Modified Davis classification, without pupil dilation, acquired with a NIDEK AFC-230
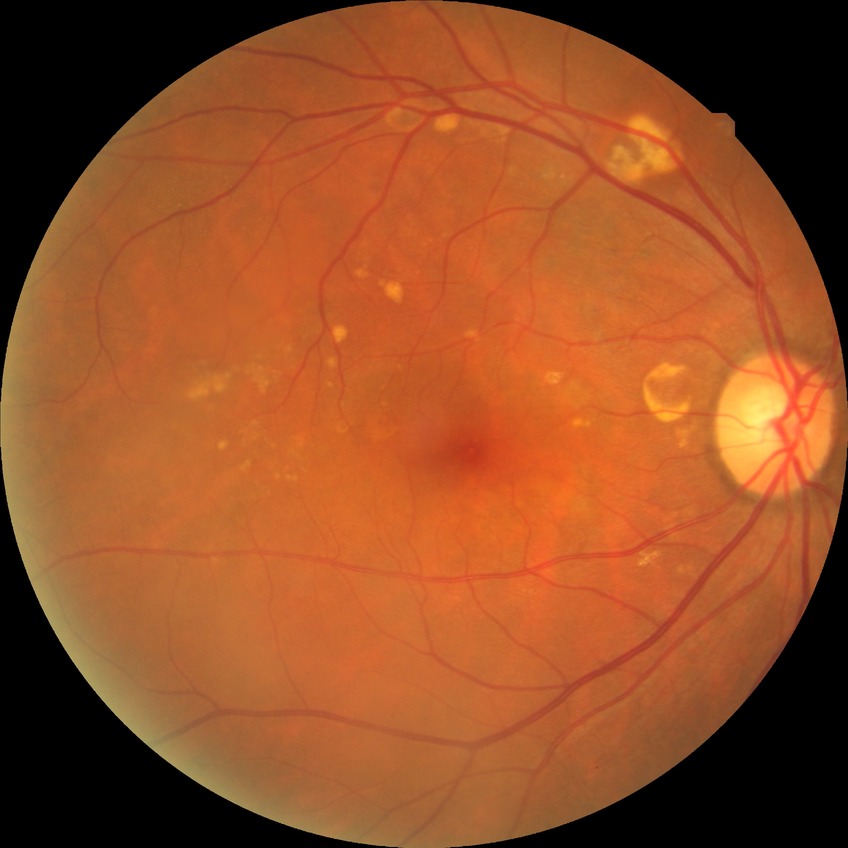 diabetic retinopathy (DR): NDR (no diabetic retinopathy).